Image size 2352x1568. Color fundus photograph
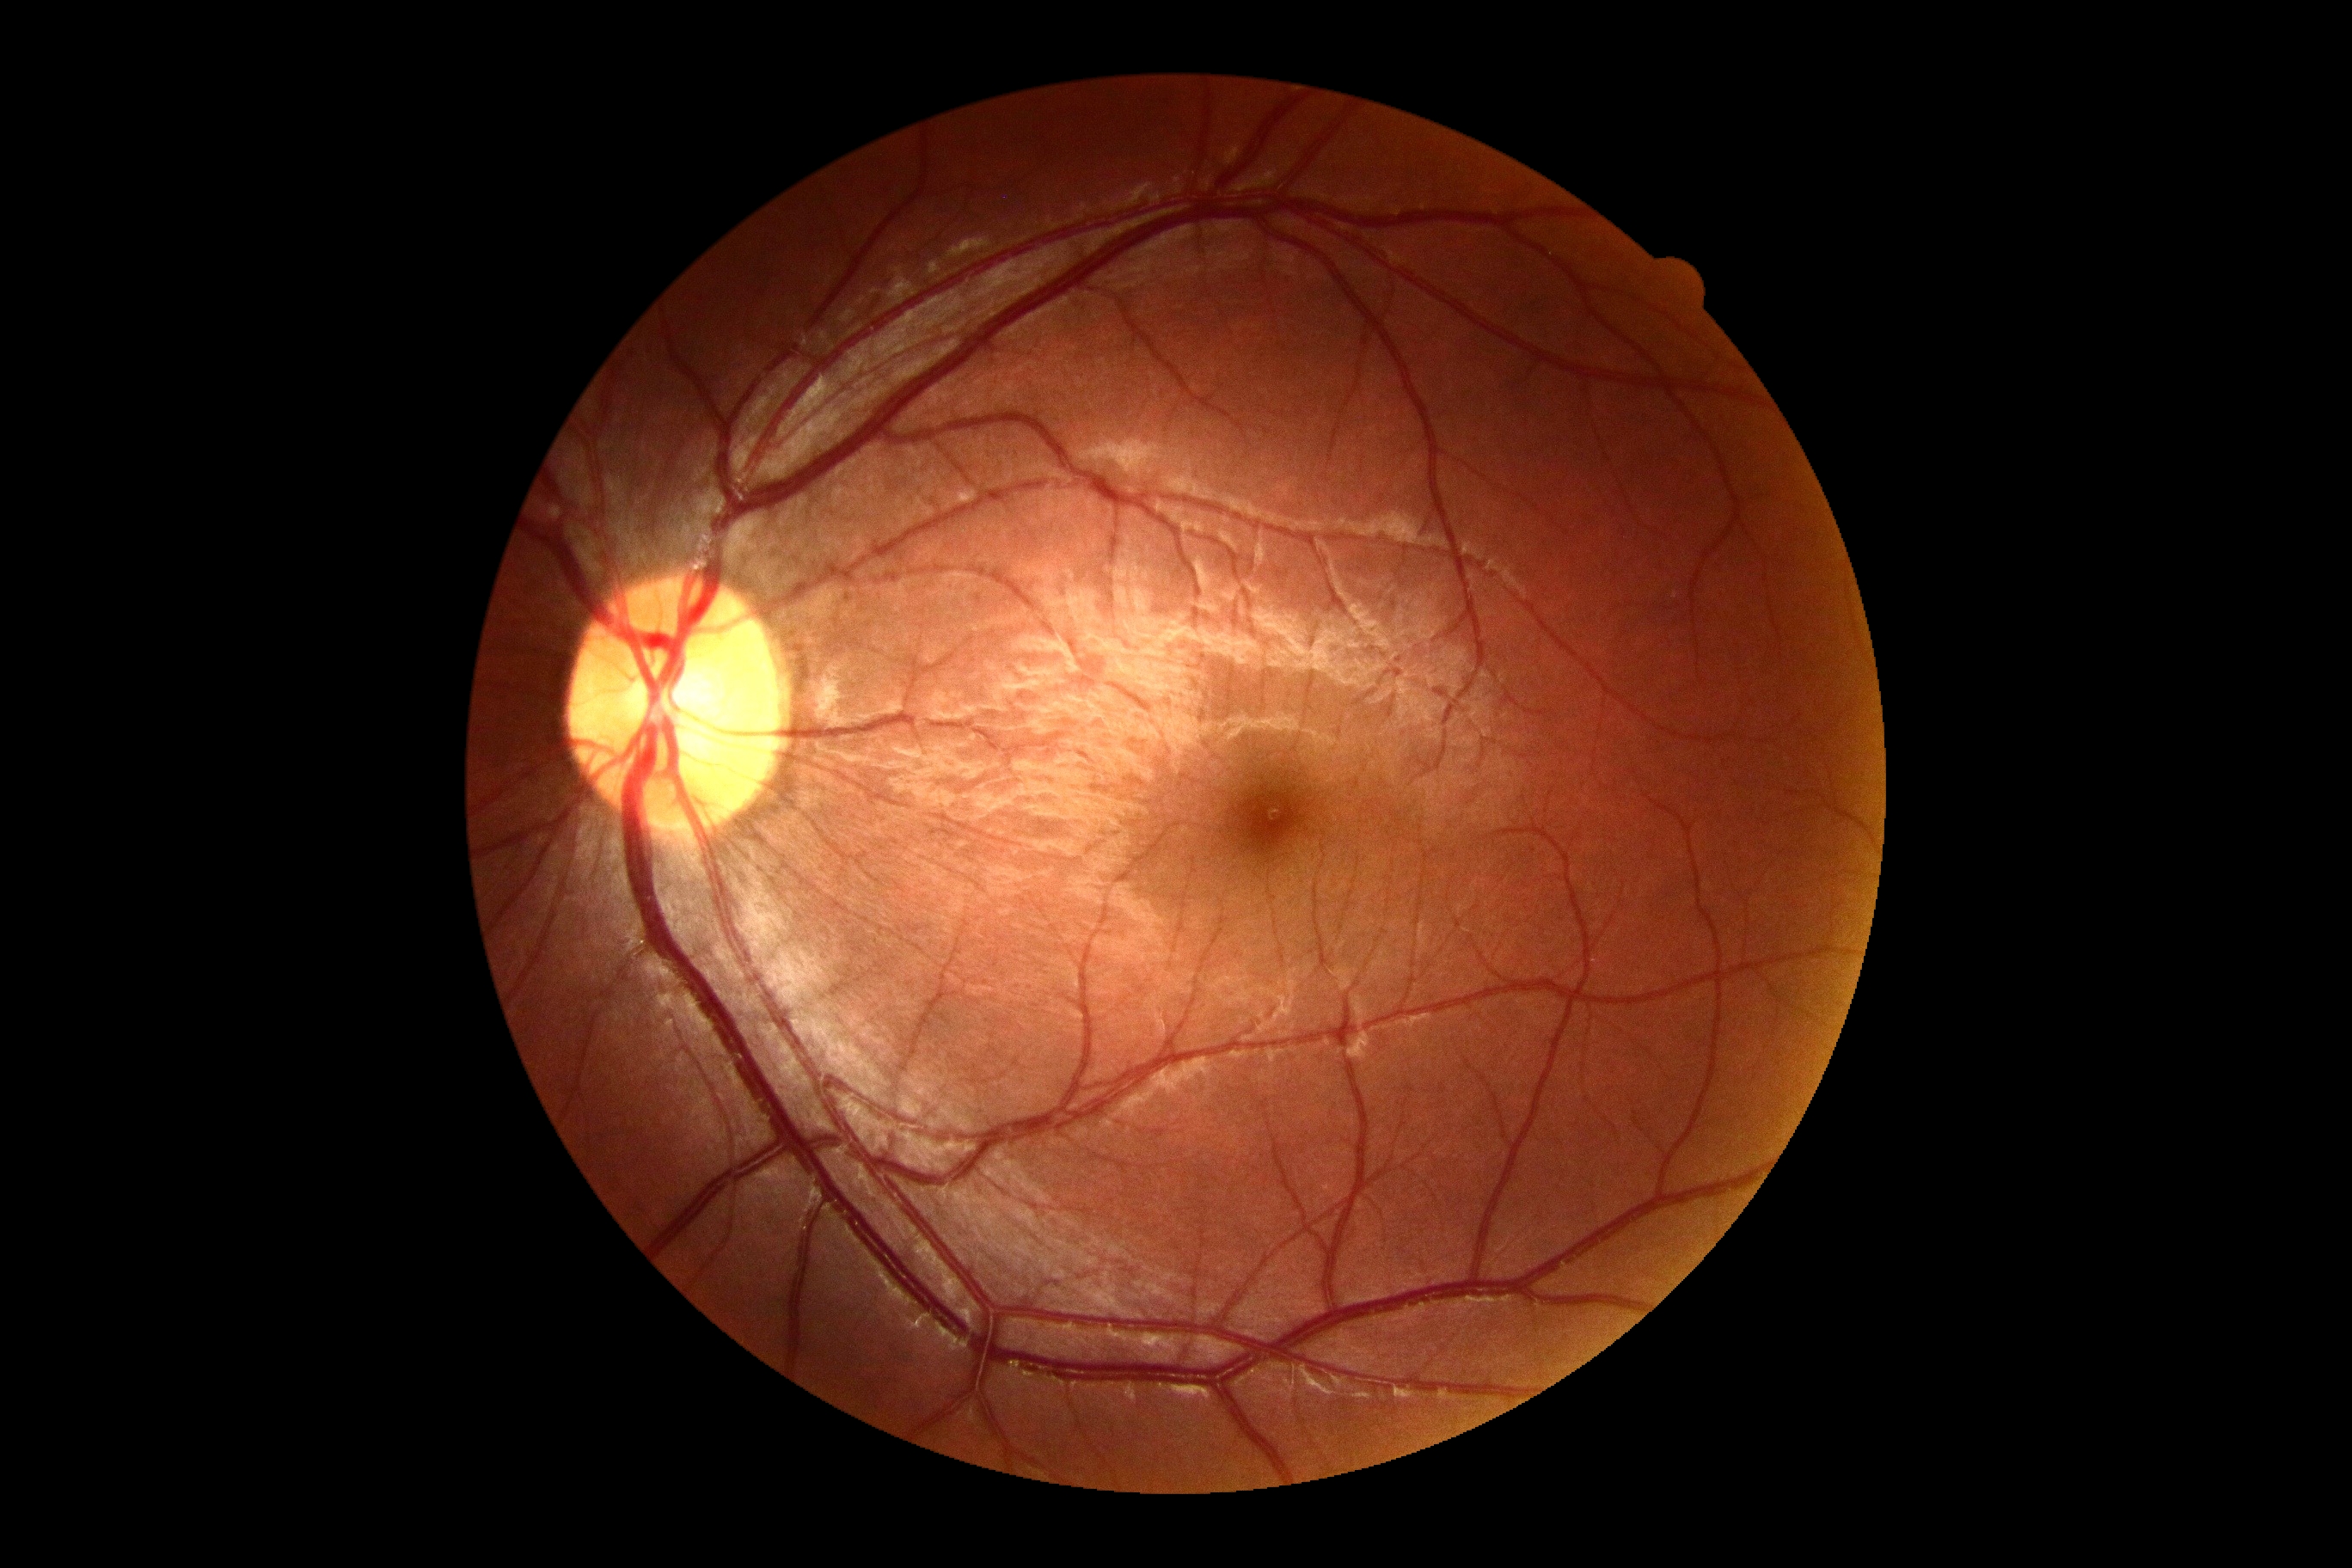 No DR findings. DR severity is grade 0 (no apparent retinopathy).